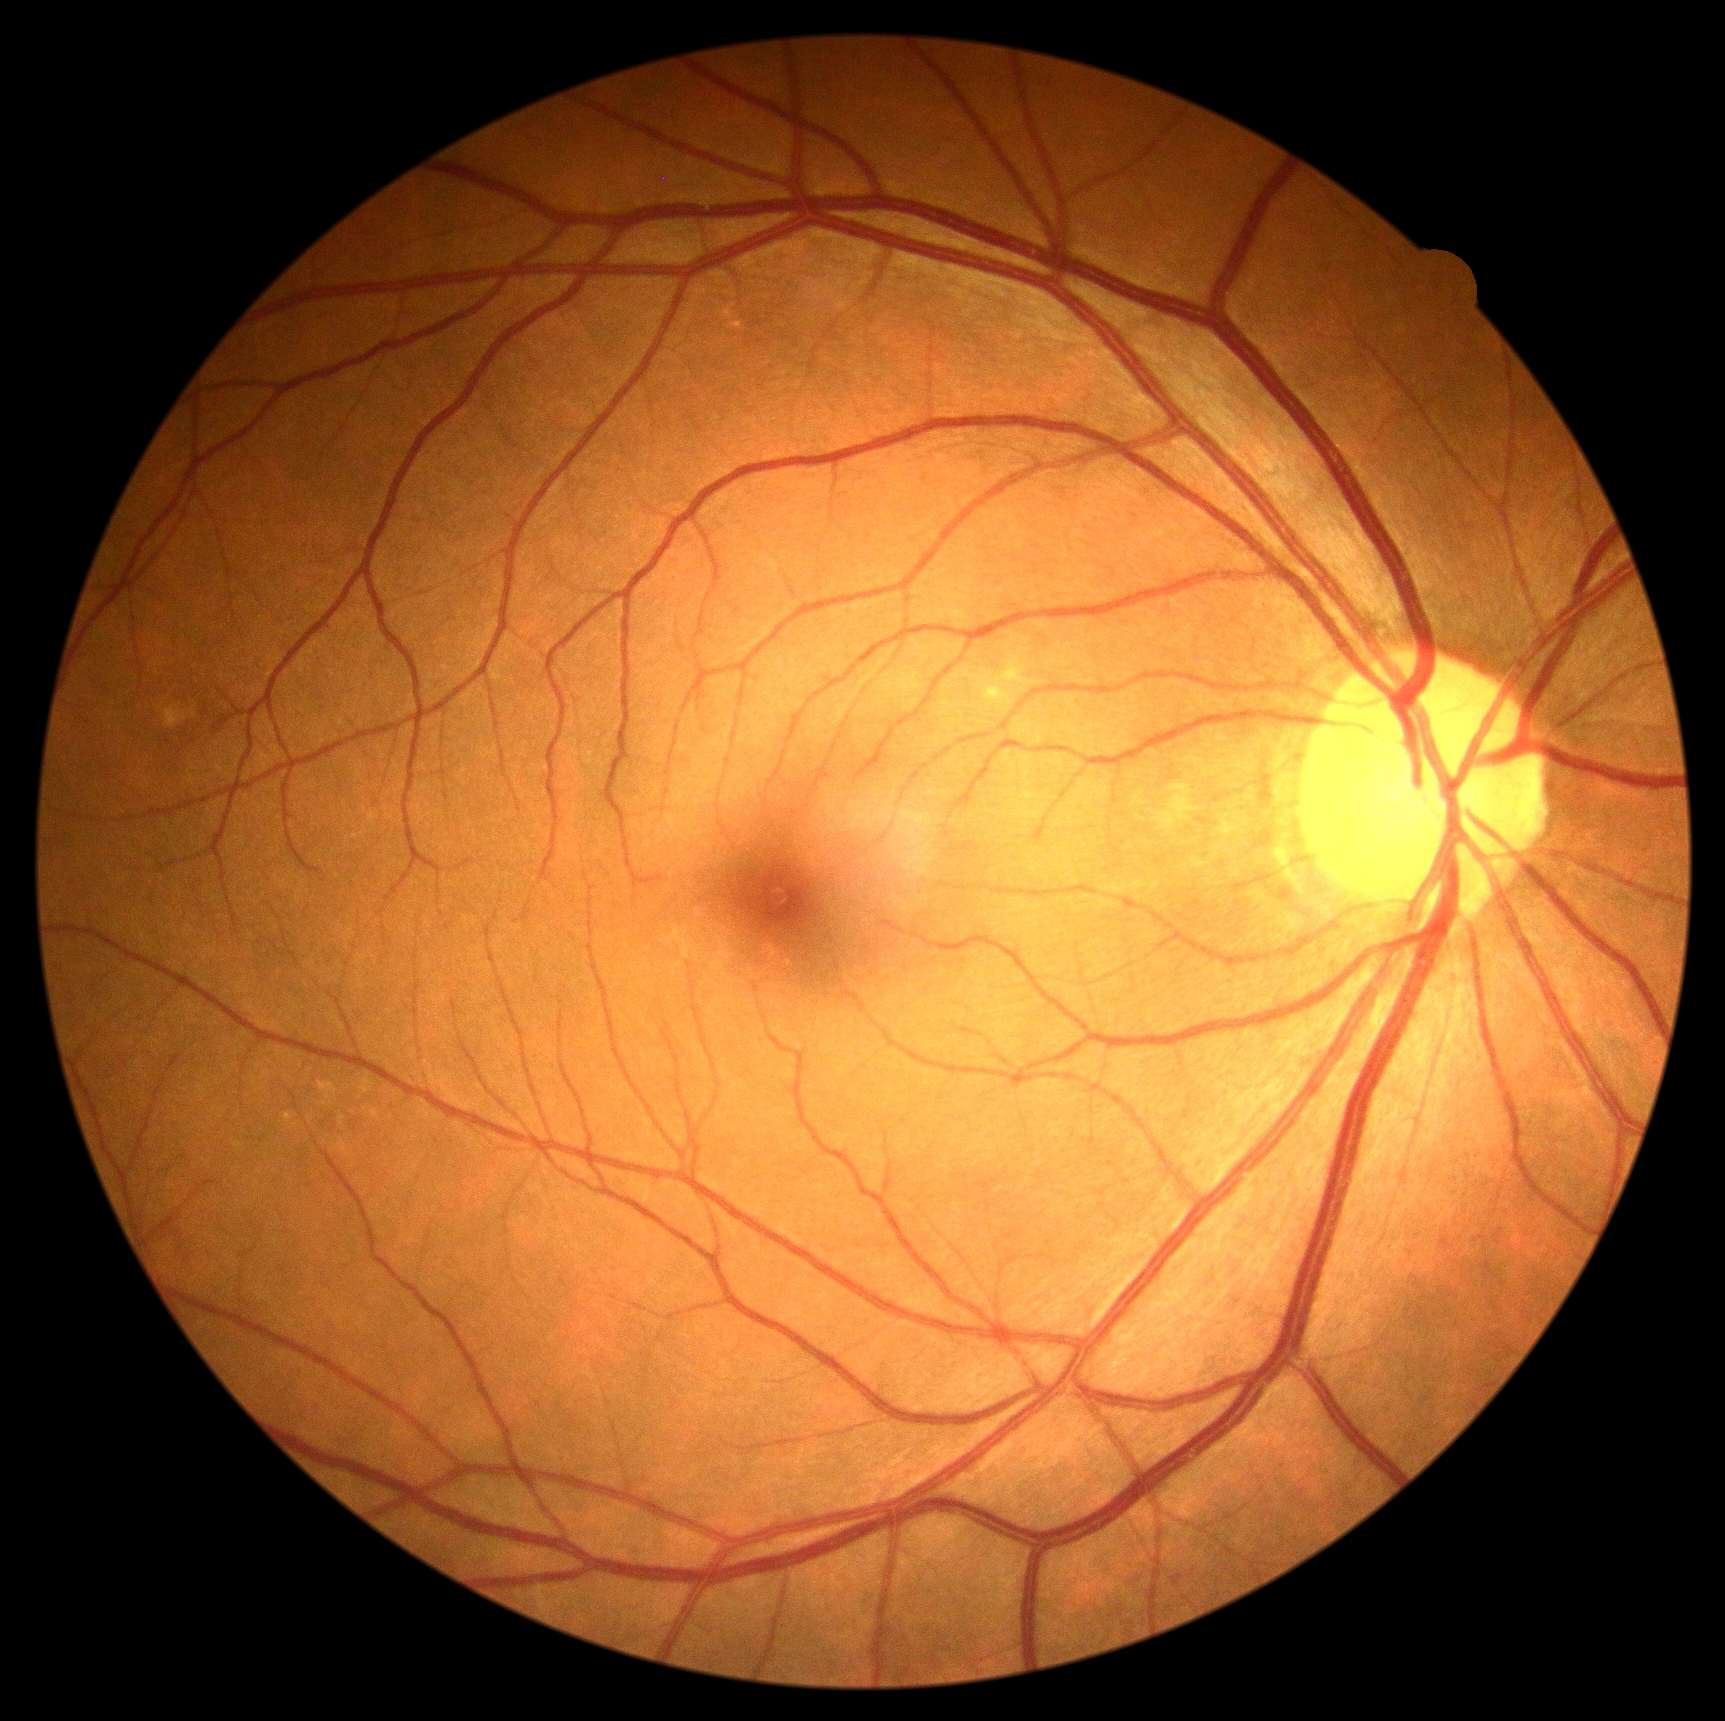

diabetic retinopathy (DR)@no apparent retinopathy (grade 0).